1240x1240 · camera: Phoenix ICON (100° FOV) · Phoenix ICON wide-field infant fundus image: 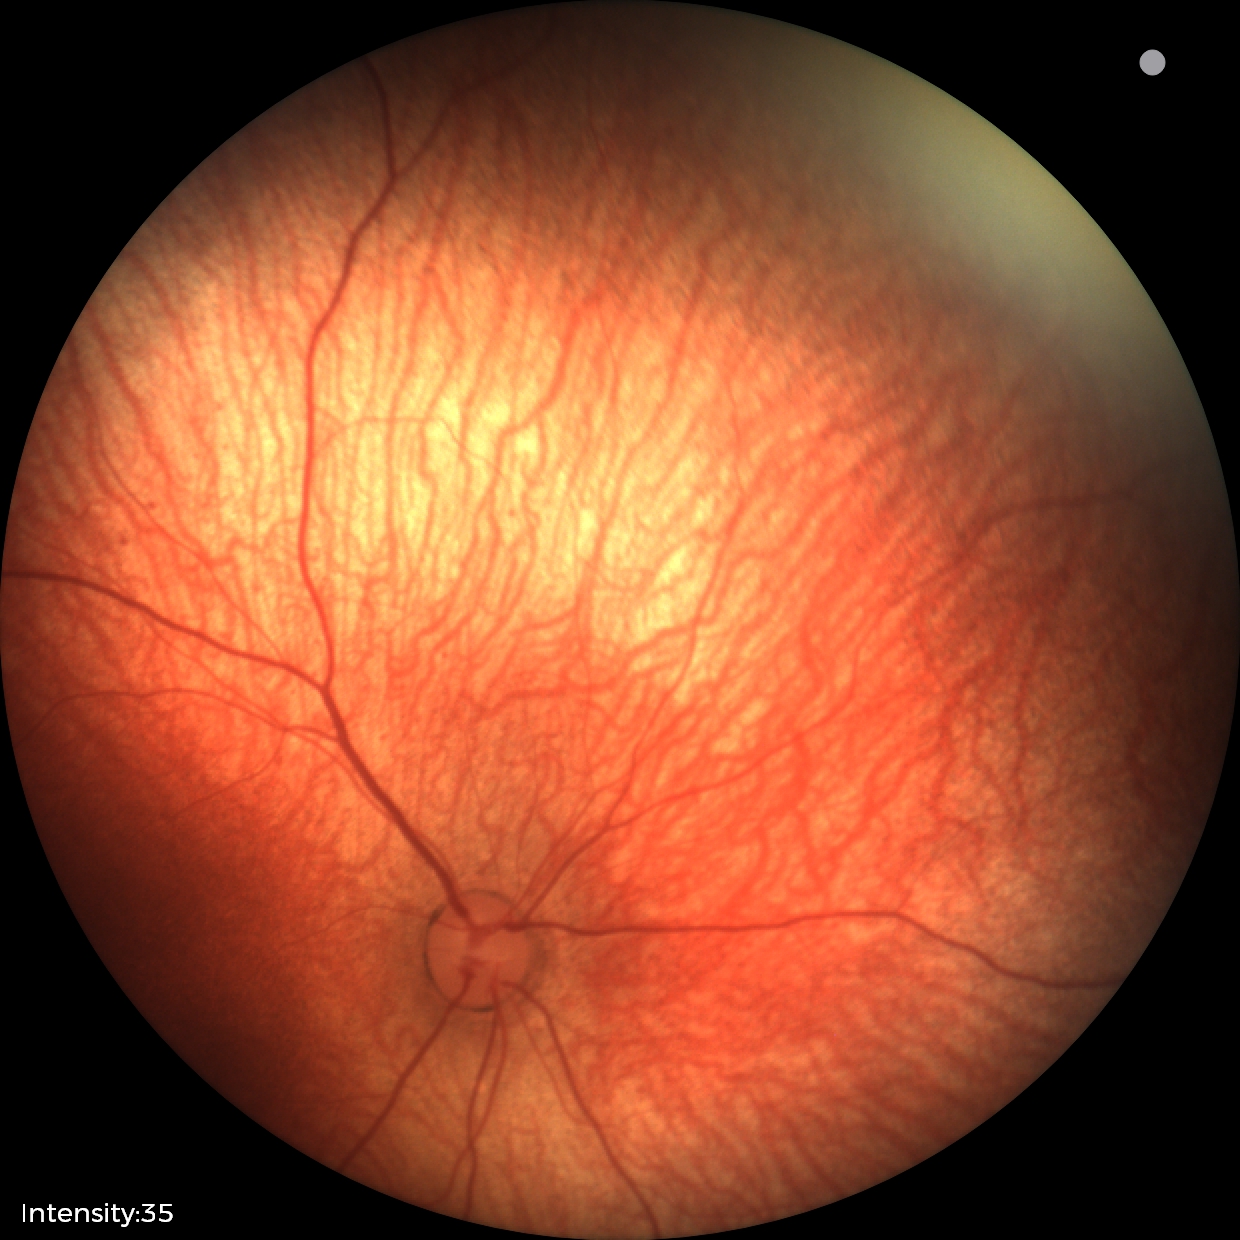
Assessment: physiological appearance.